1924x1556:
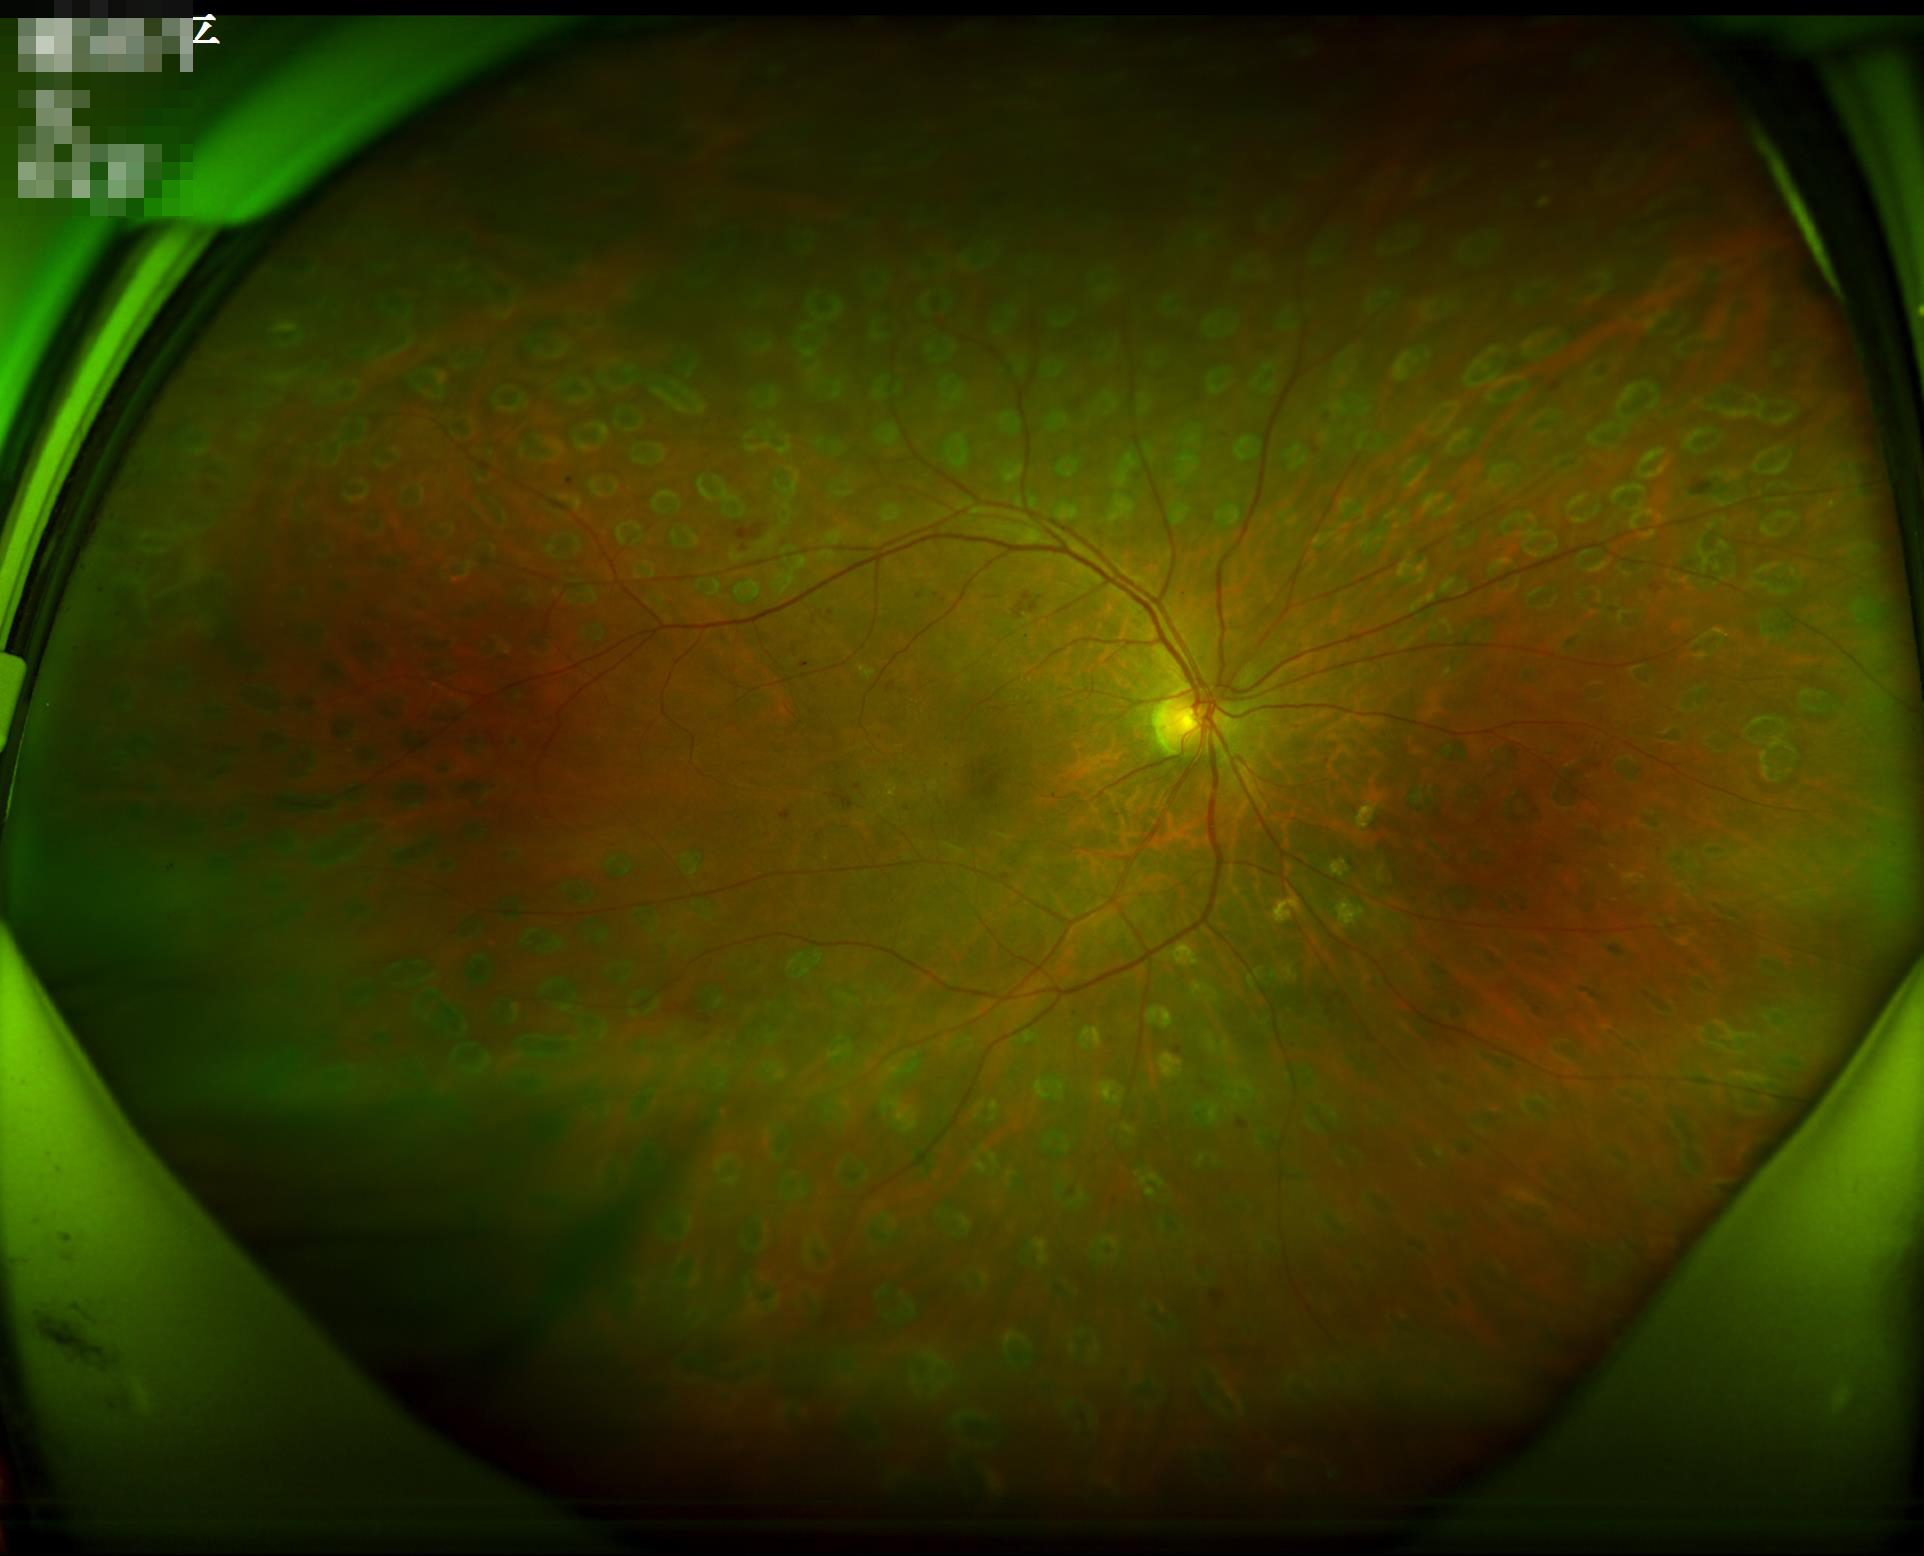 Overall image quality is good.
The image is clear.
Vessels and details are readily distinguishable.
Illumination is even.